CFP: 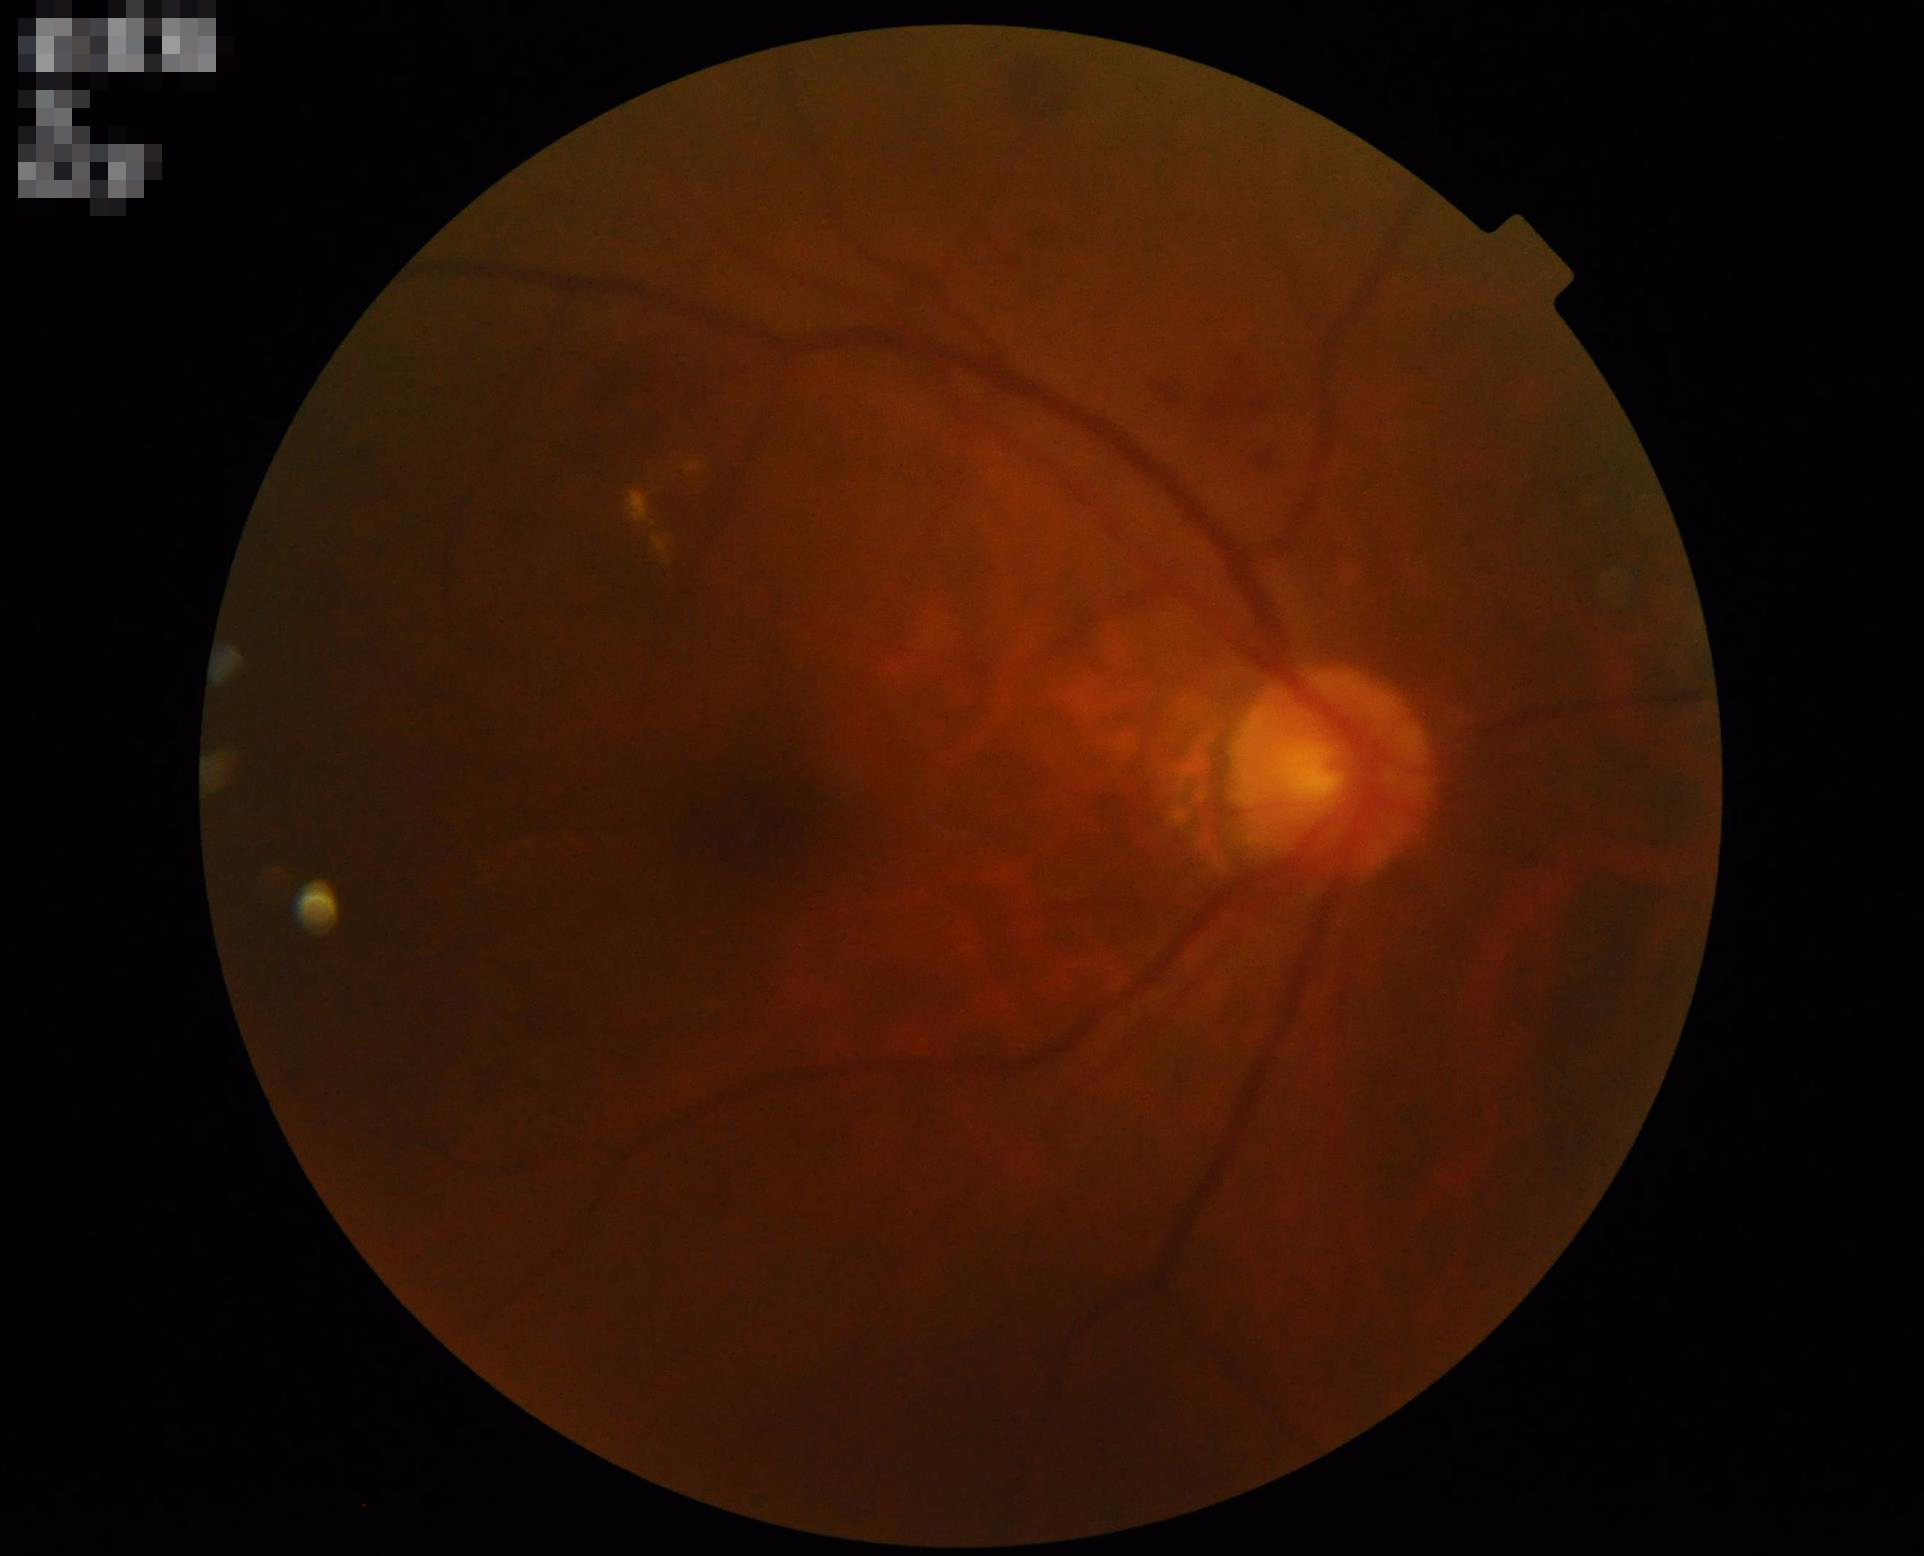
Overall quality is poor; the image is difficult to grade. Poor dynamic range. Illumination and color are suboptimal. Noticeable blur in the optic disc, vessels, or background.